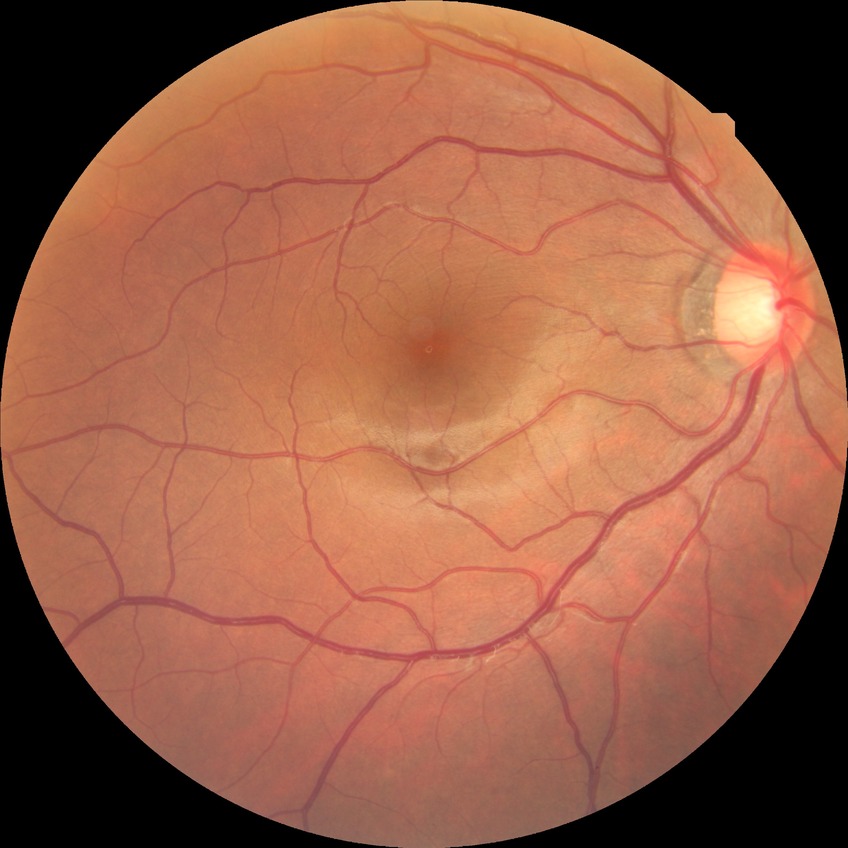

Assessment:
- retinopathy grade — no diabetic retinopathy